Nonmydriatic · CFP — 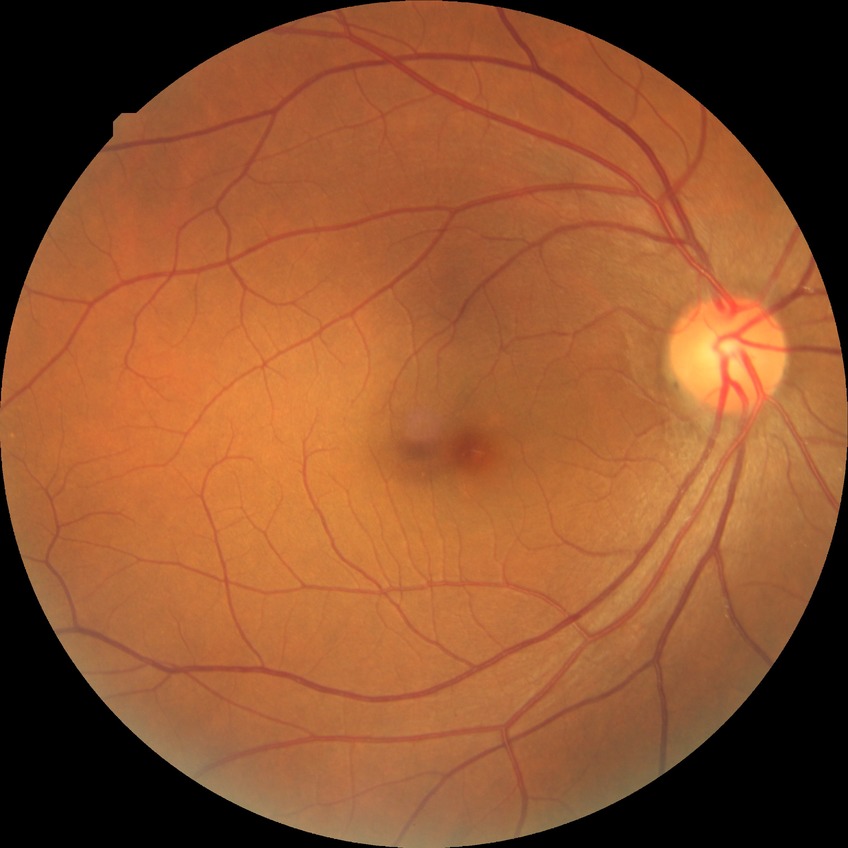
Modified Davis classification is no diabetic retinopathy.